1960x1897px; 45-degree field of view.
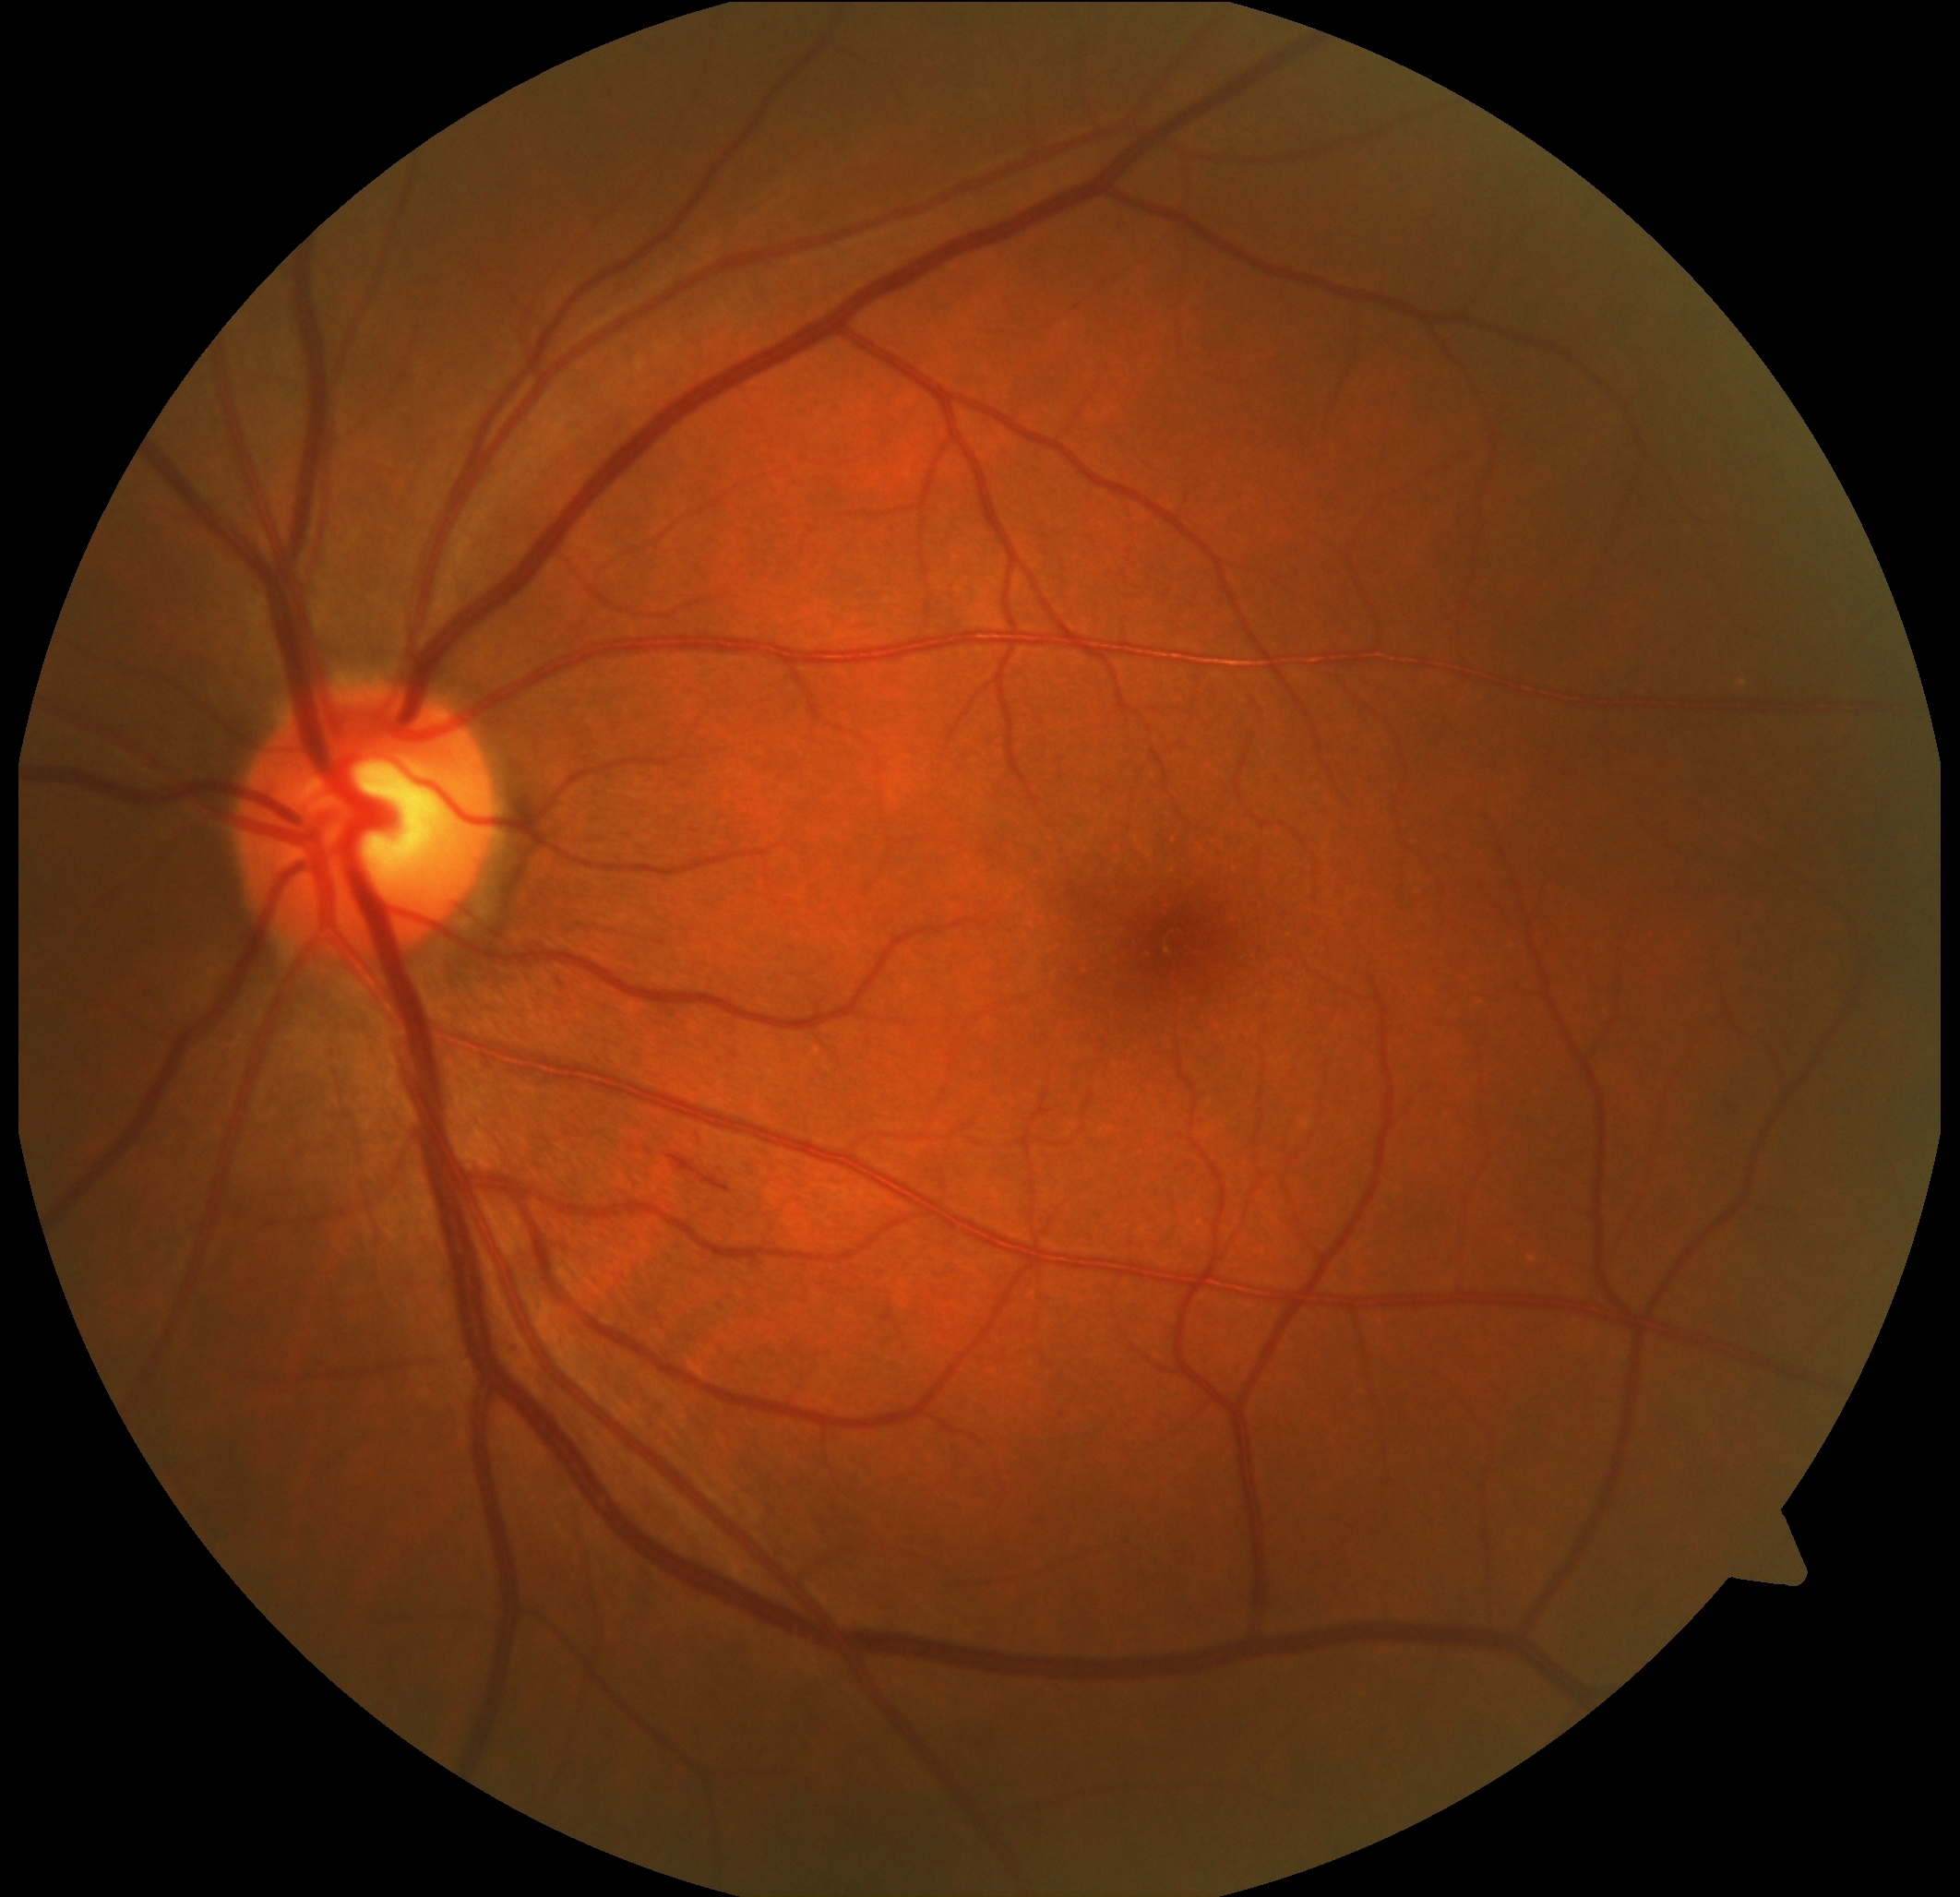
dr_grade: moderate non-proliferative diabetic retinopathy (grade 2)